Image size 1920x1440, color fundus photograph:
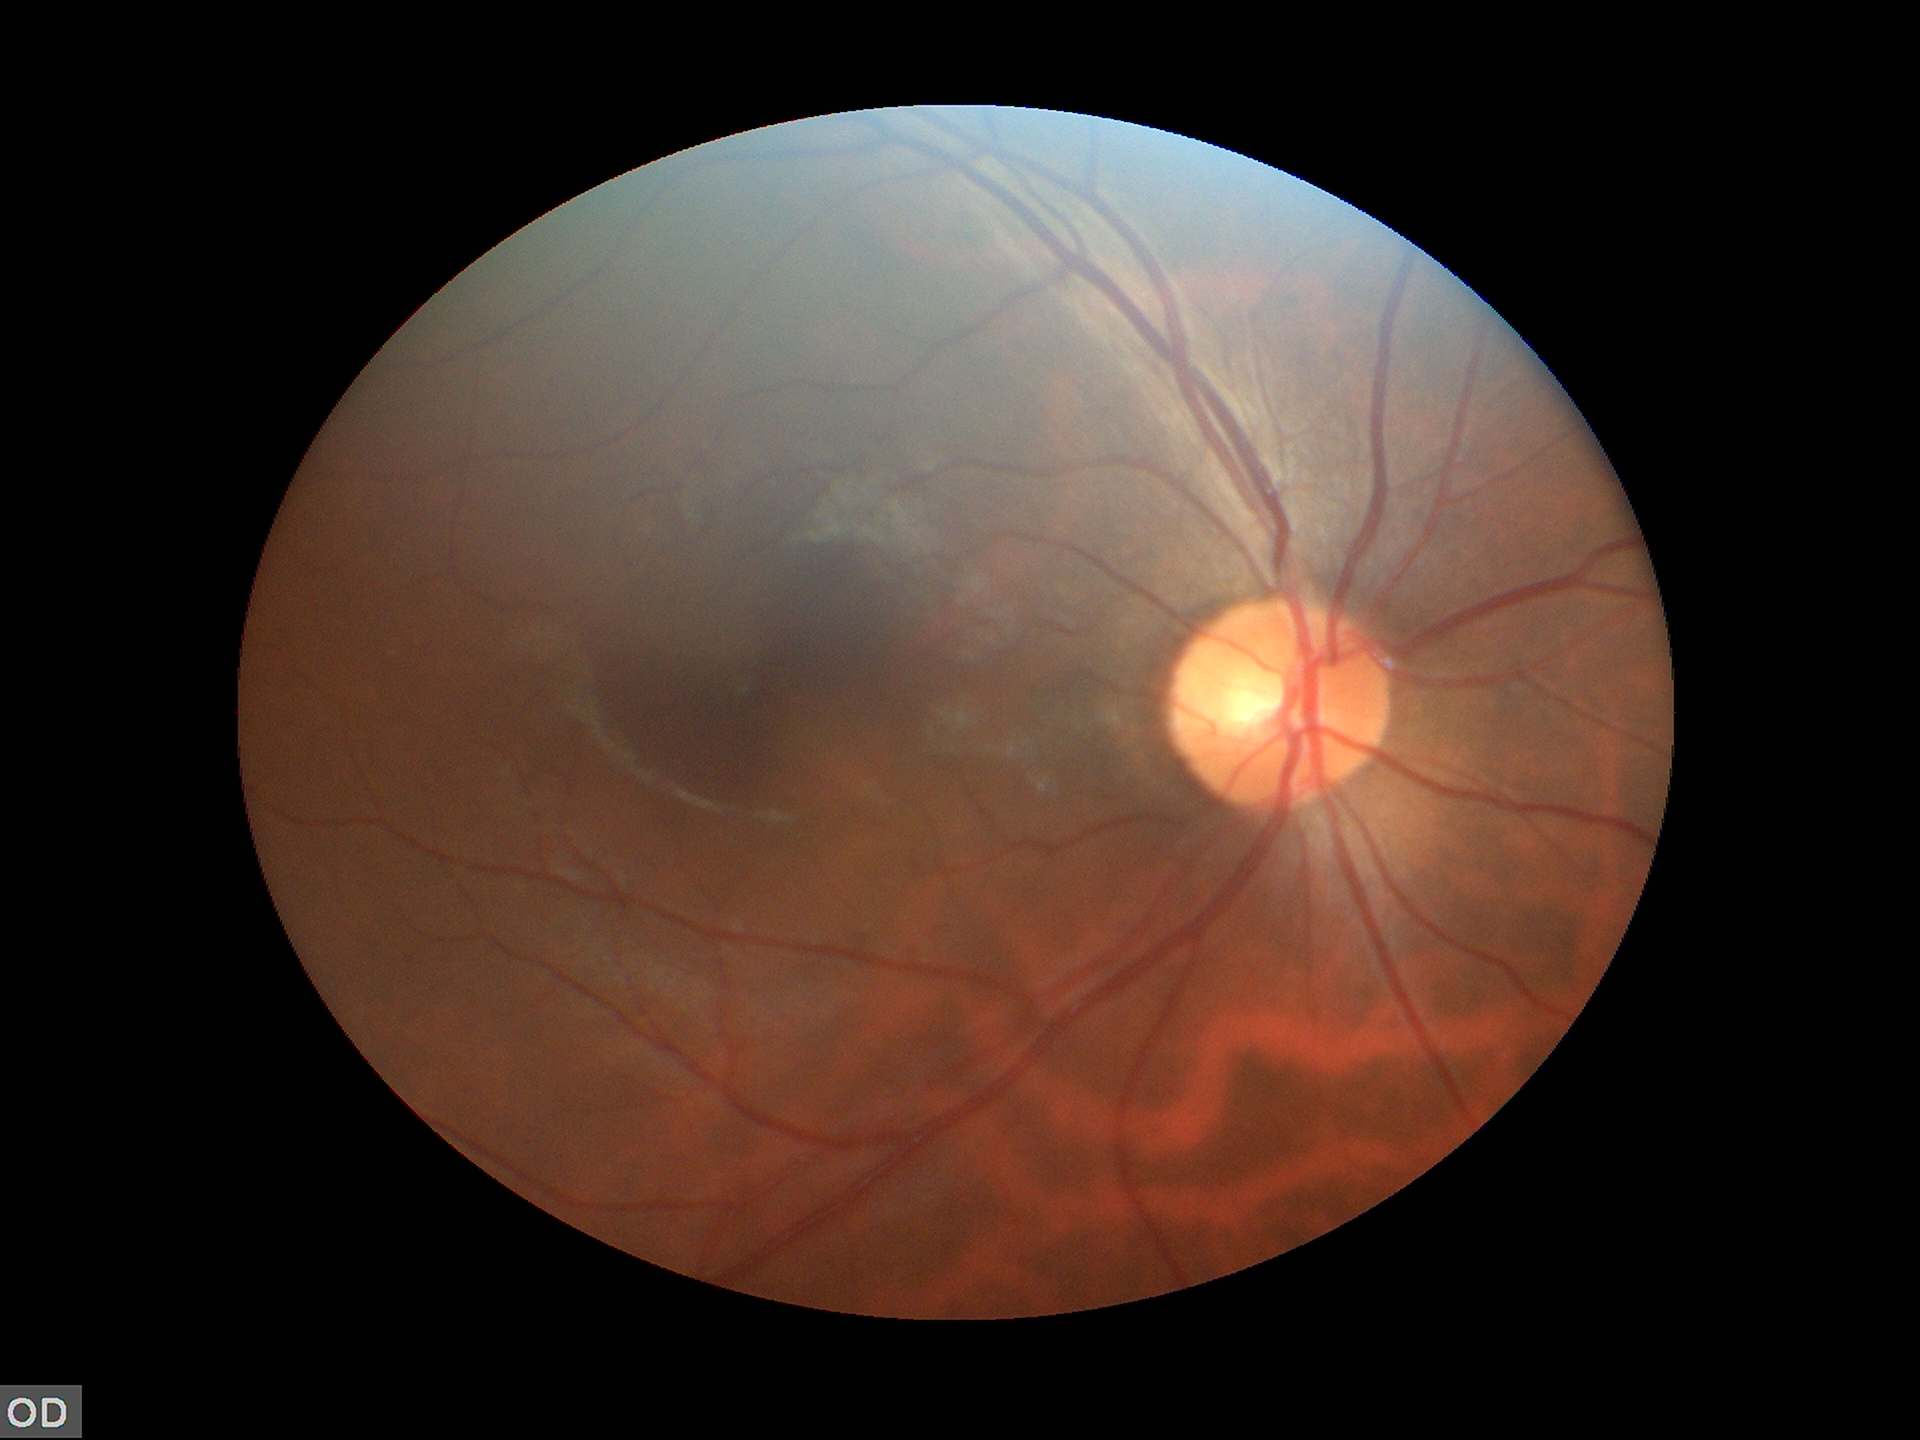 Glaucoma evaluation: not suspect.
Vertical cup-disc ratio (VCDR) is 0.48.
Horizontal CDR (HCDR) is 0.47.